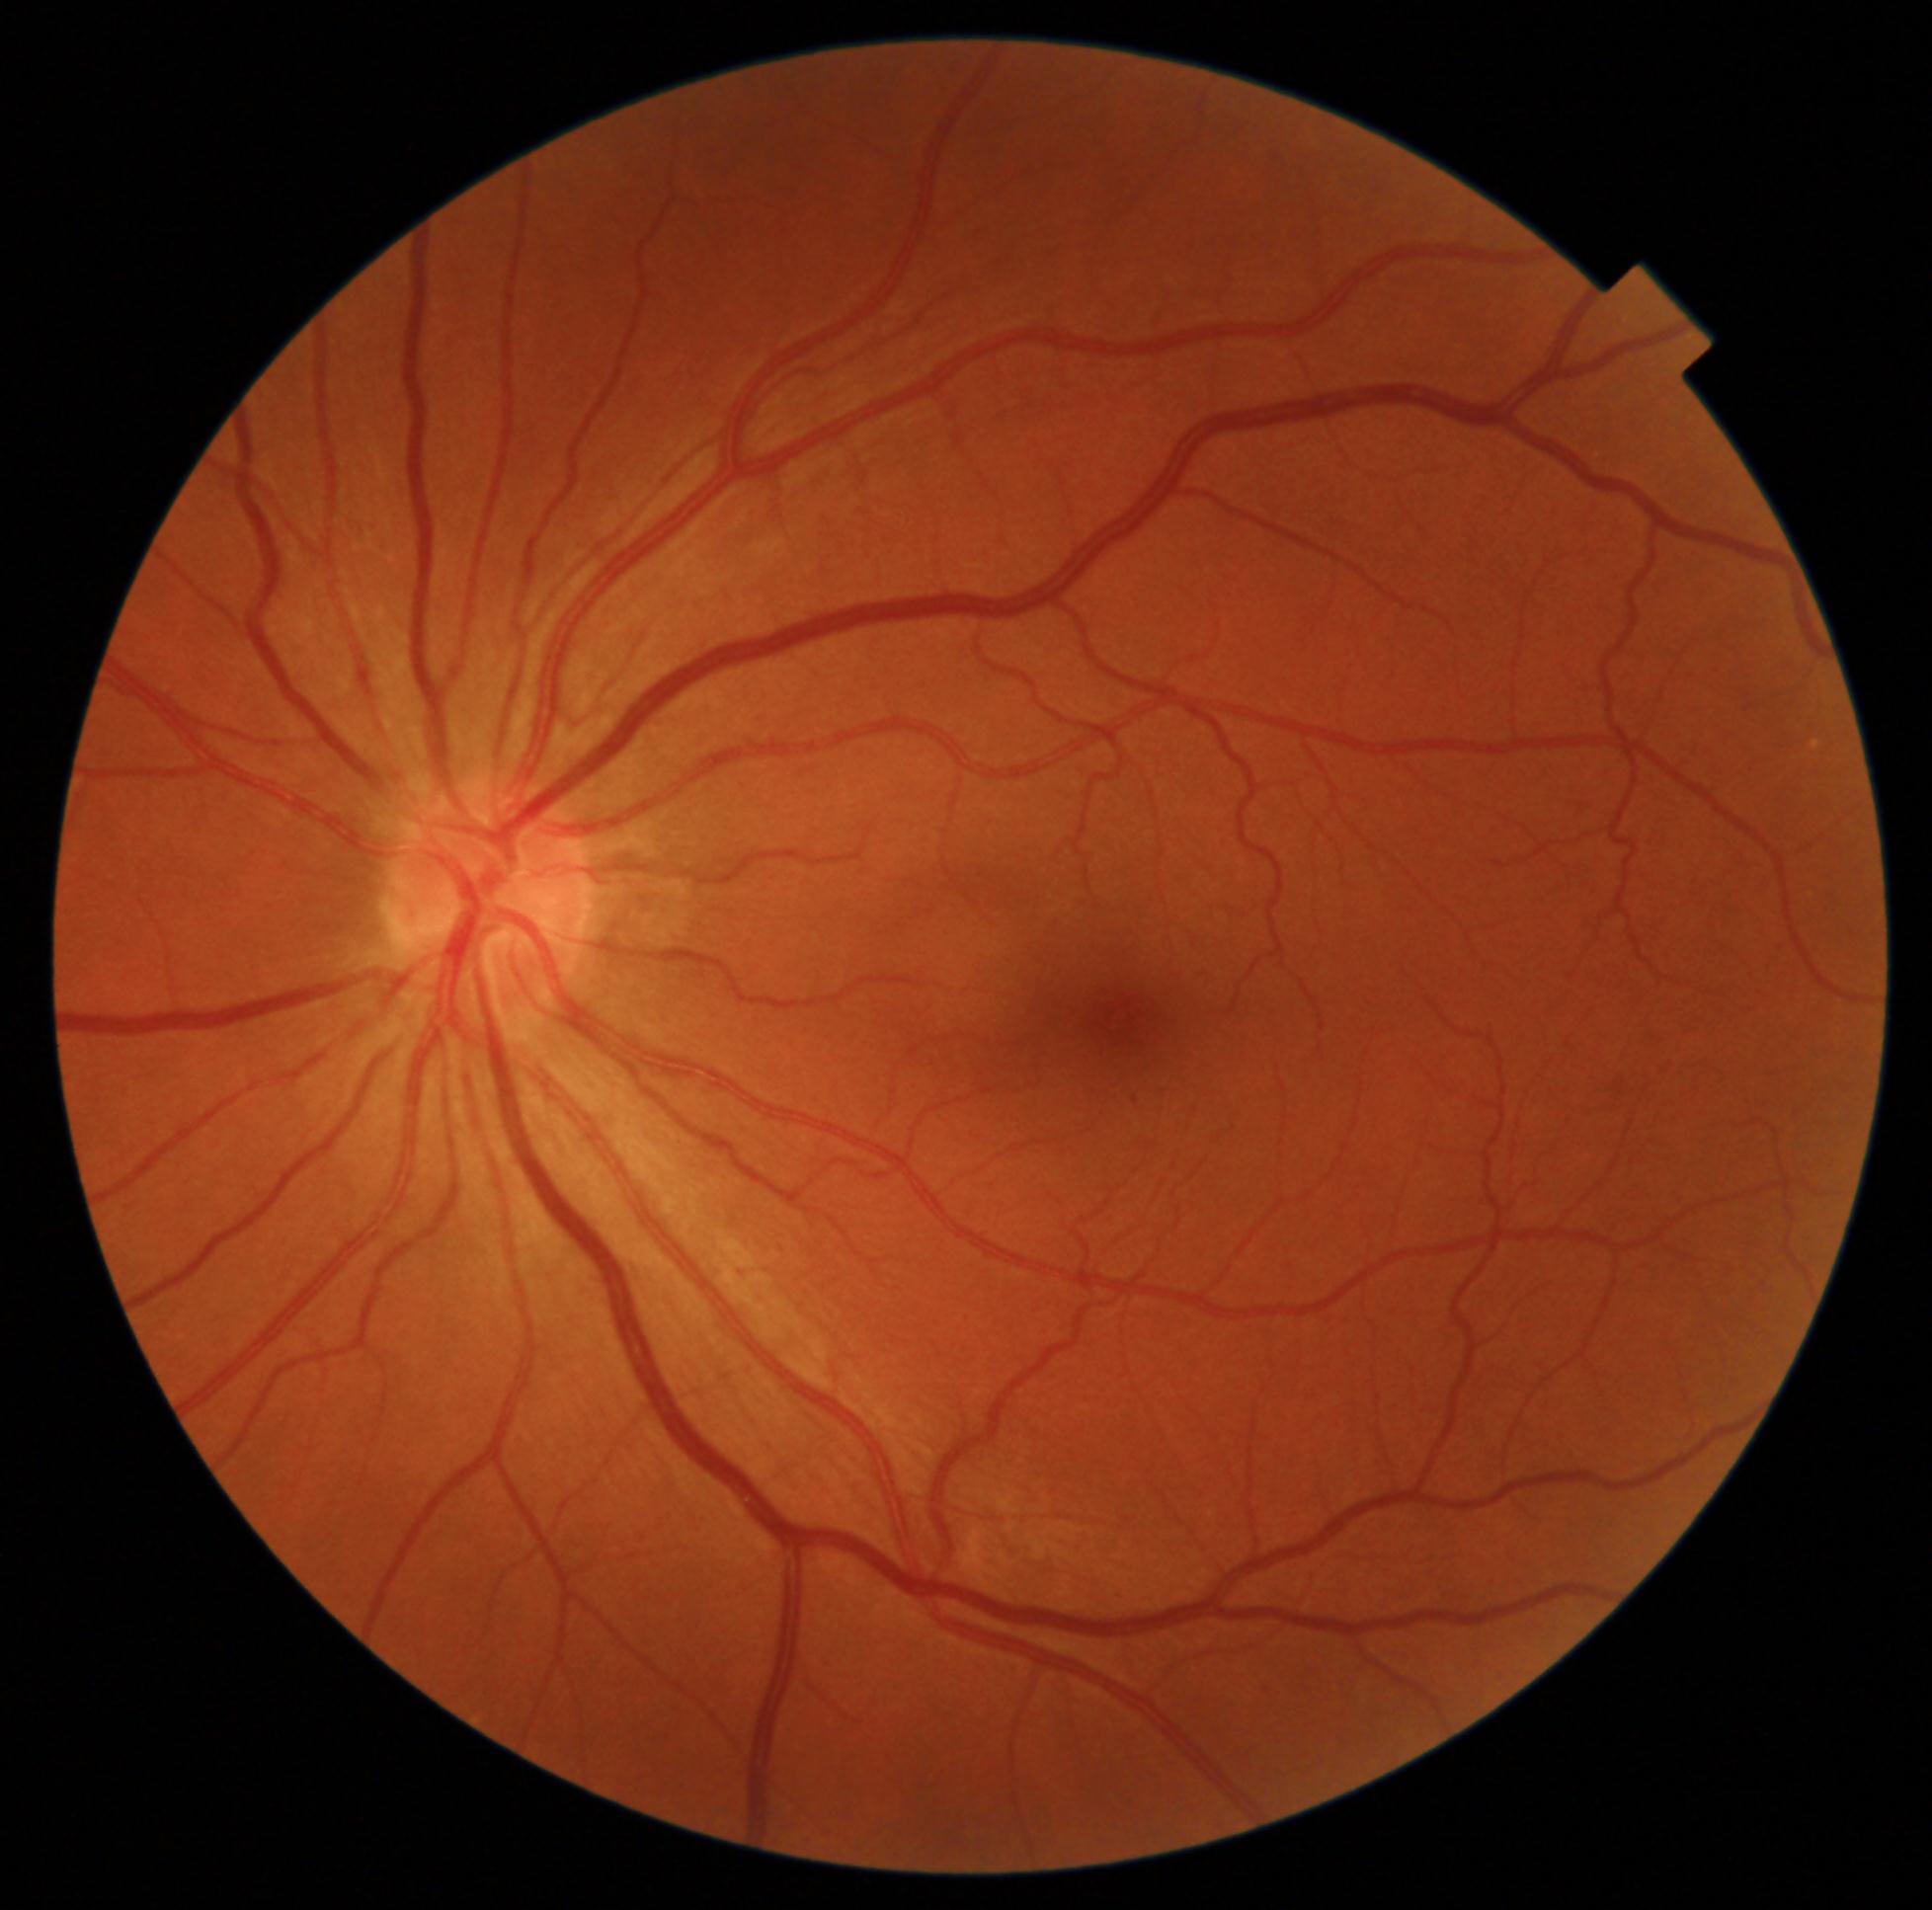 DR severity: mild NPDR (grade 1).